Posterior pole color fundus photograph; 848 by 848 pixels; FOV: 45 degrees; nonmydriatic fundus photograph:
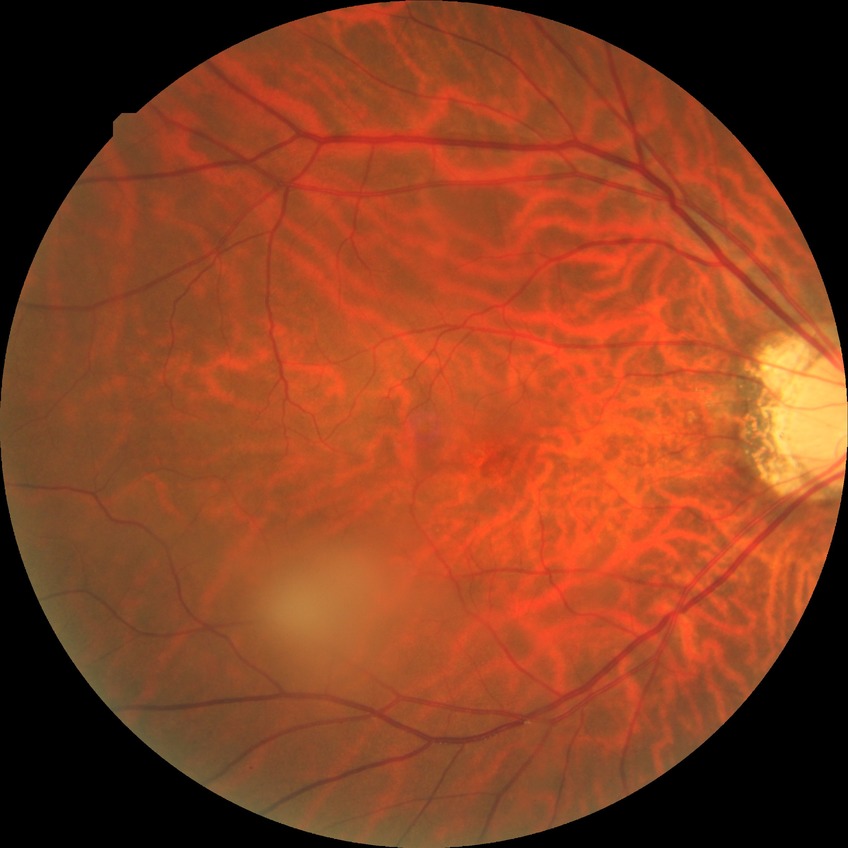

diabetic retinopathy (DR)@NDR (no diabetic retinopathy).